Portable fundus camera image · 60° FOV · 2212 x 1659 pixels — 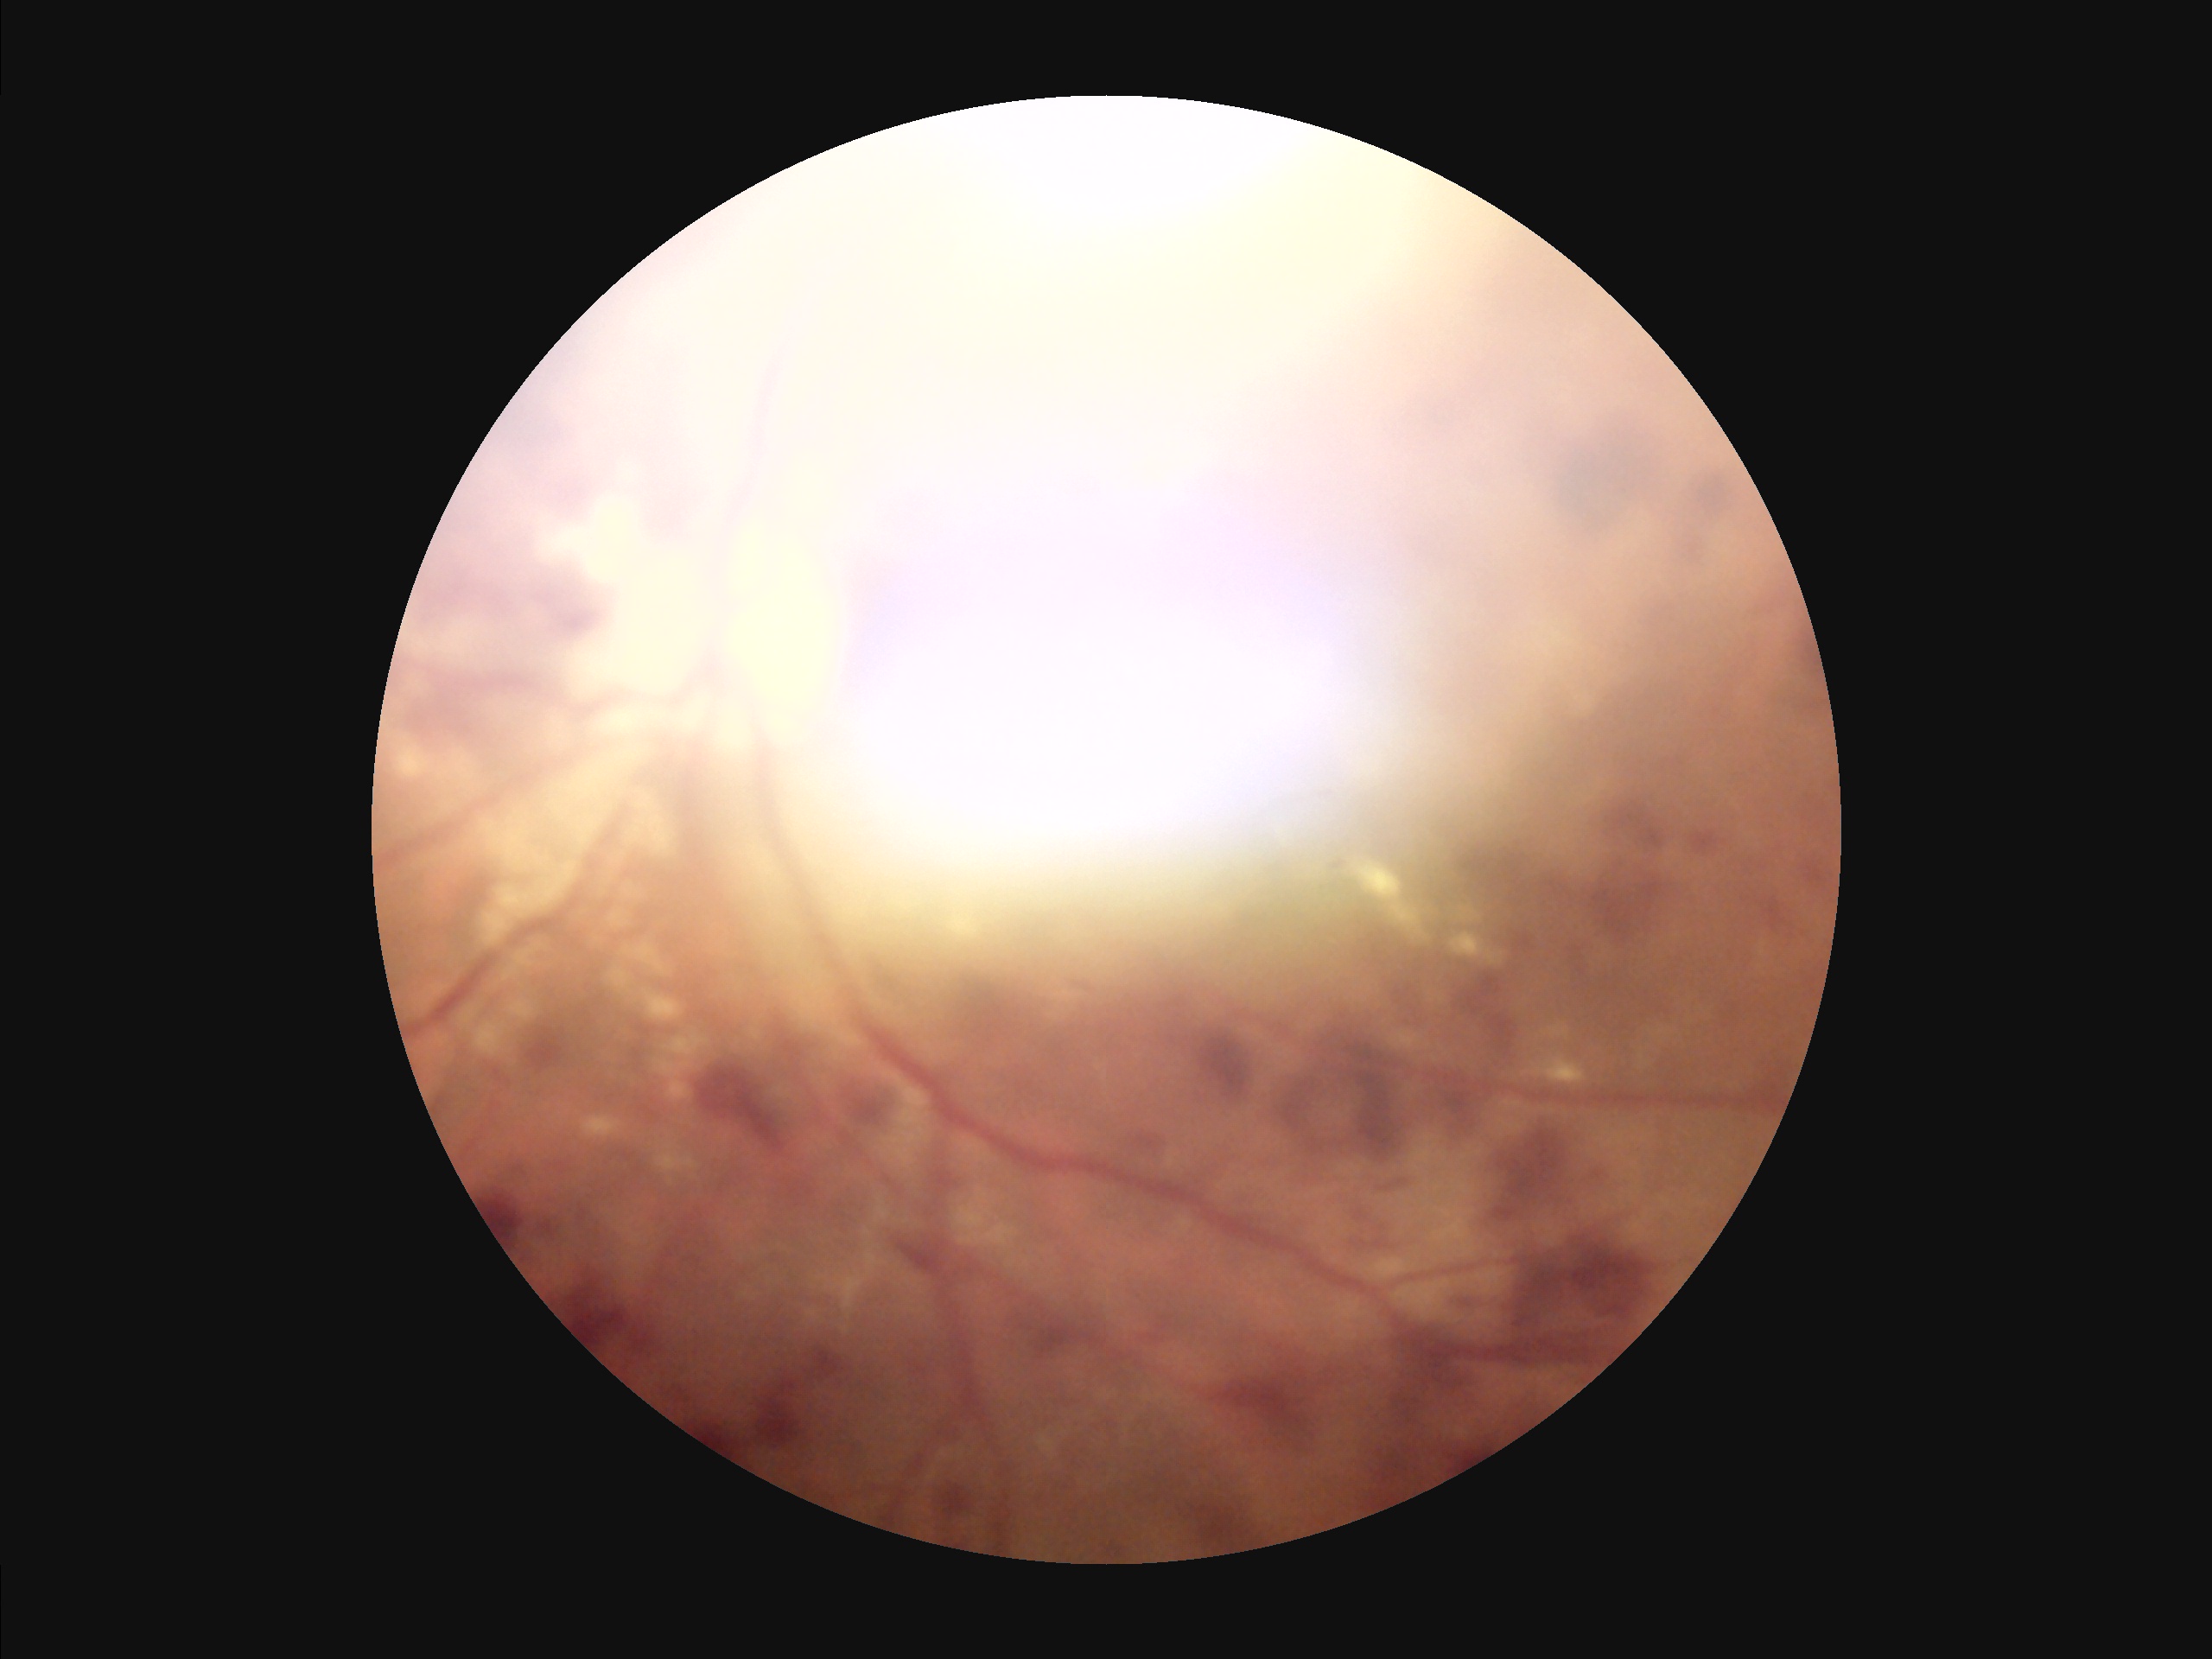

Illumination: suboptimal; Contrast: poor; Overall image quality: suboptimal; Focus: blurry.